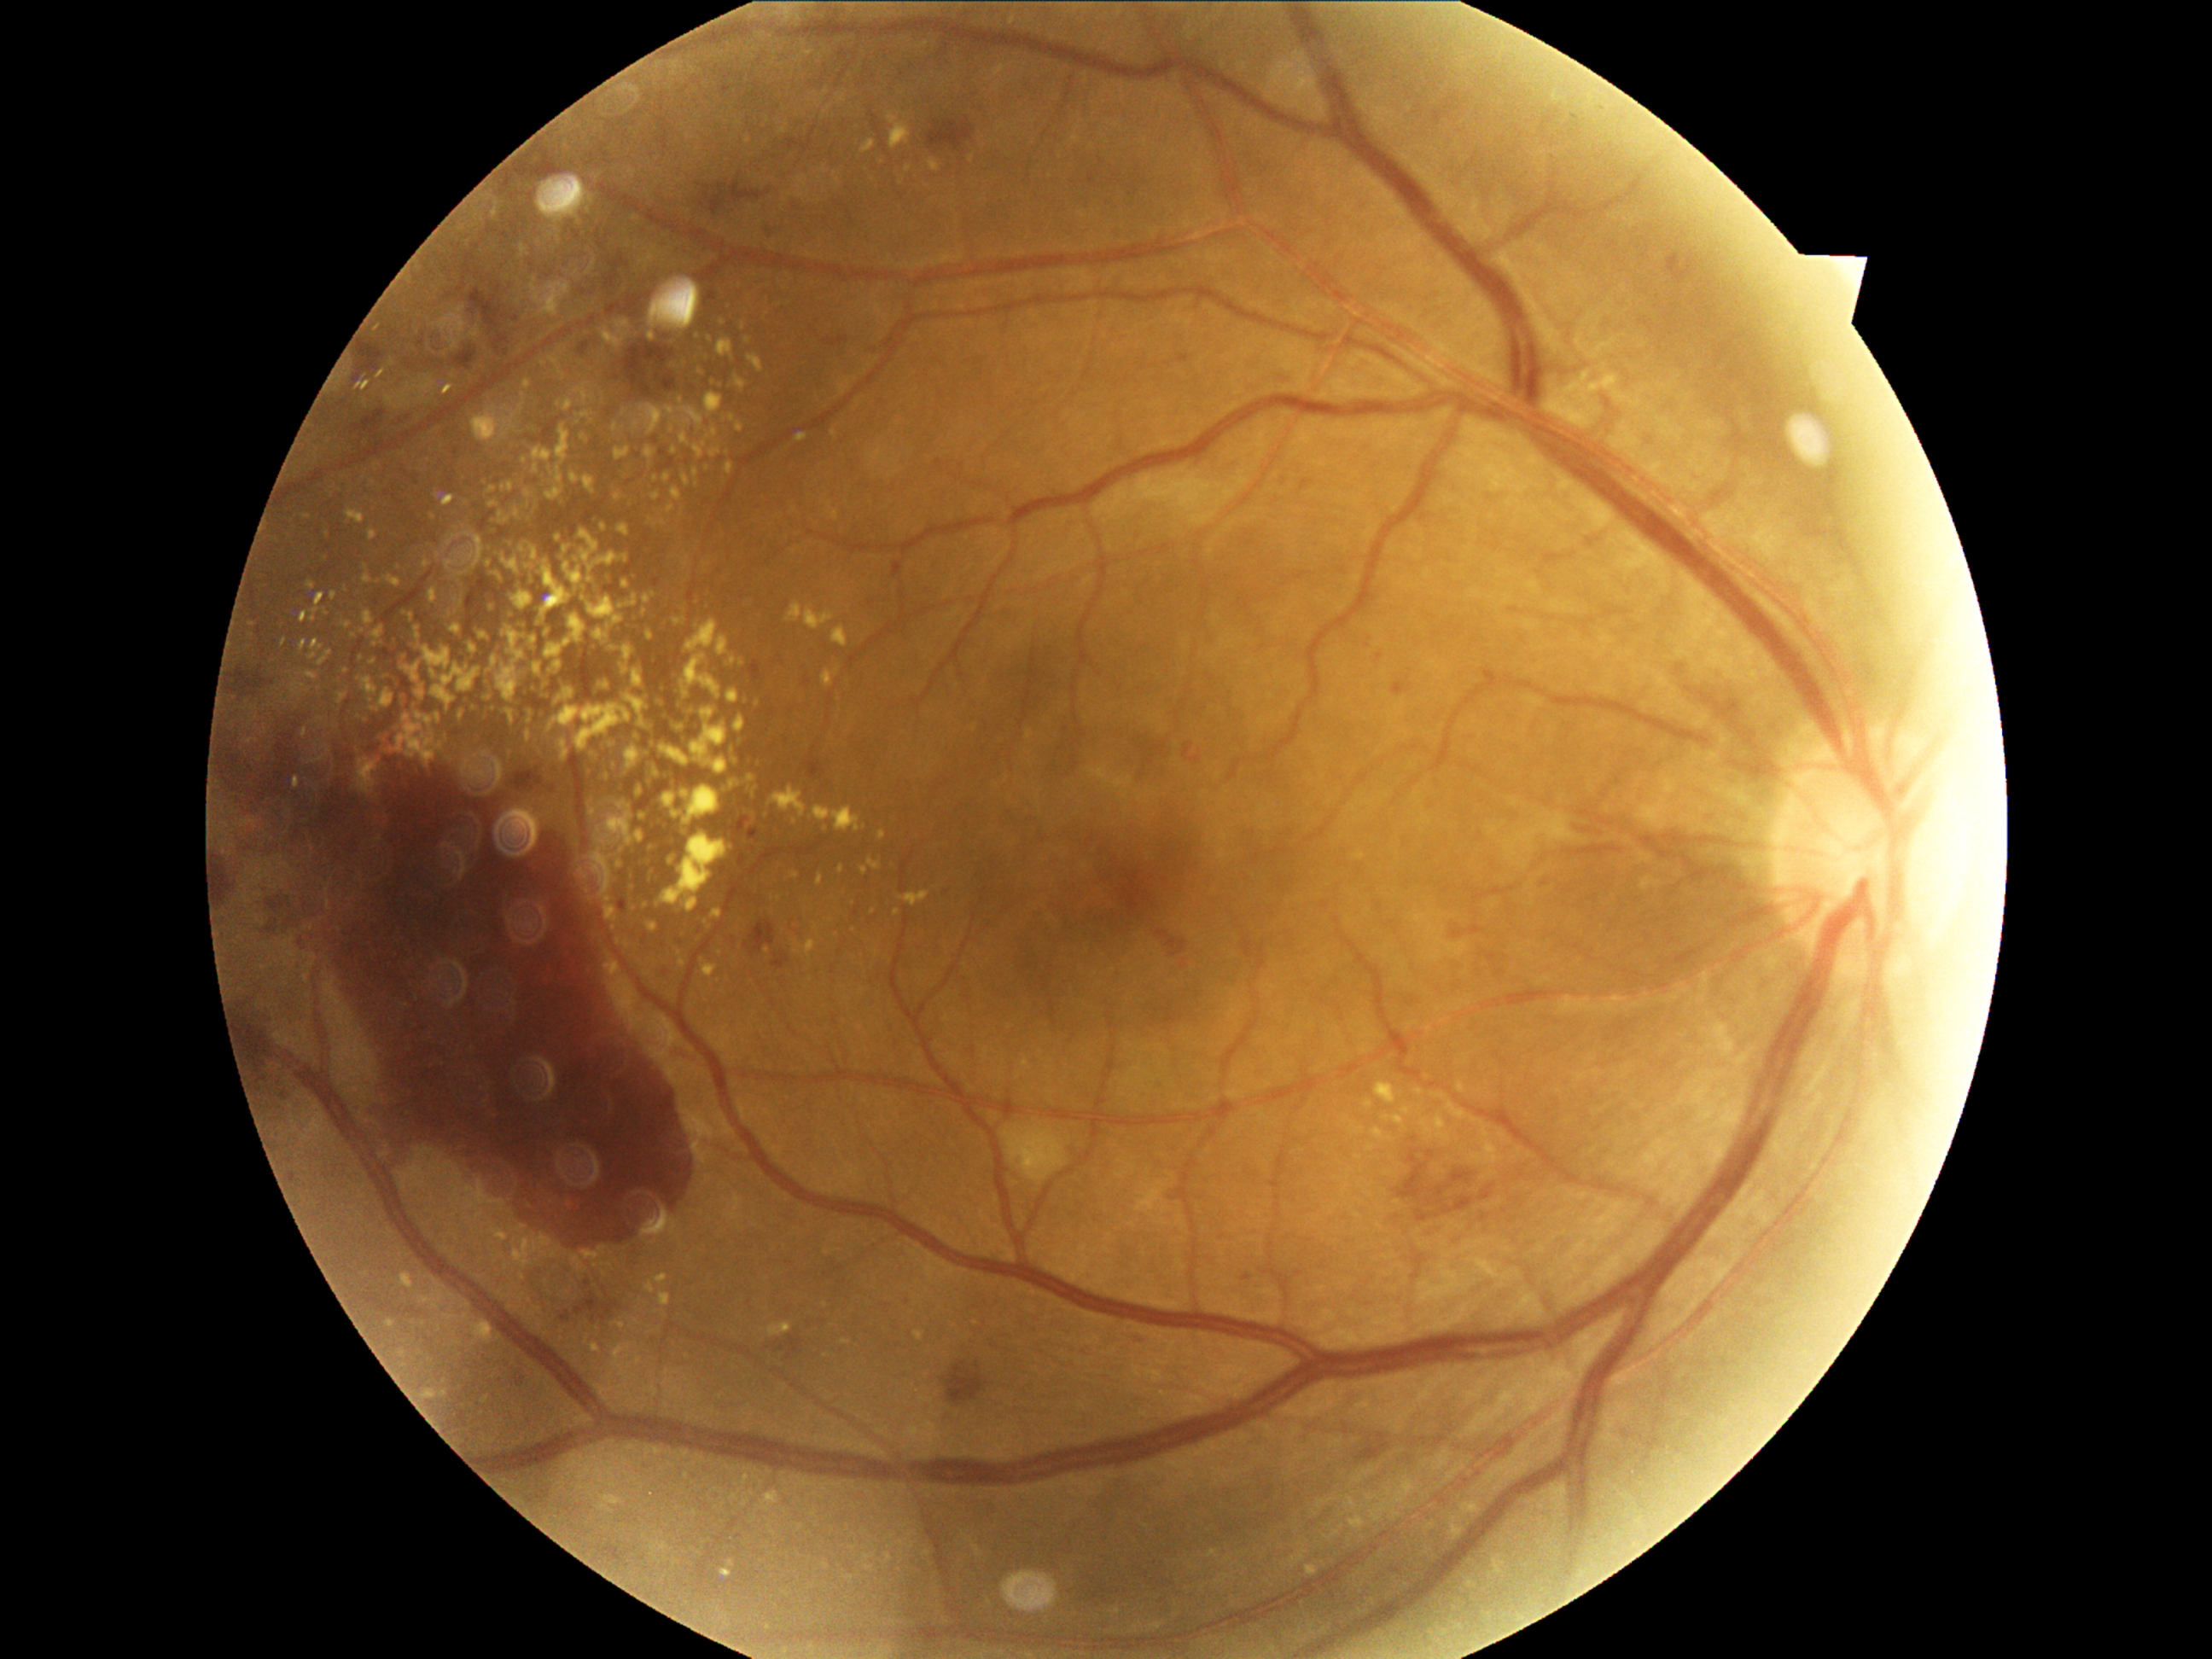
Diabetic retinopathy (DR) is 4/4
A subset of detected lesions:
hard exudates (EXs) (continued): (429,590,438,603) | (709,381,713,392) | (648,632,653,641) | (822,672,832,687) | (564,562,583,591) | (550,358,559,366) | (646,518,653,528) | (675,725,689,731) | (682,786,719,832) | (627,747,641,769) | (533,465,538,475) | (1486,1144,1498,1163) | (614,494,622,501)
EXs (small, approximate centers) near 482, 763 | 449, 1318 | 544, 700 | 517, 514 | 668, 478 | 621, 851